Davis DR grading: 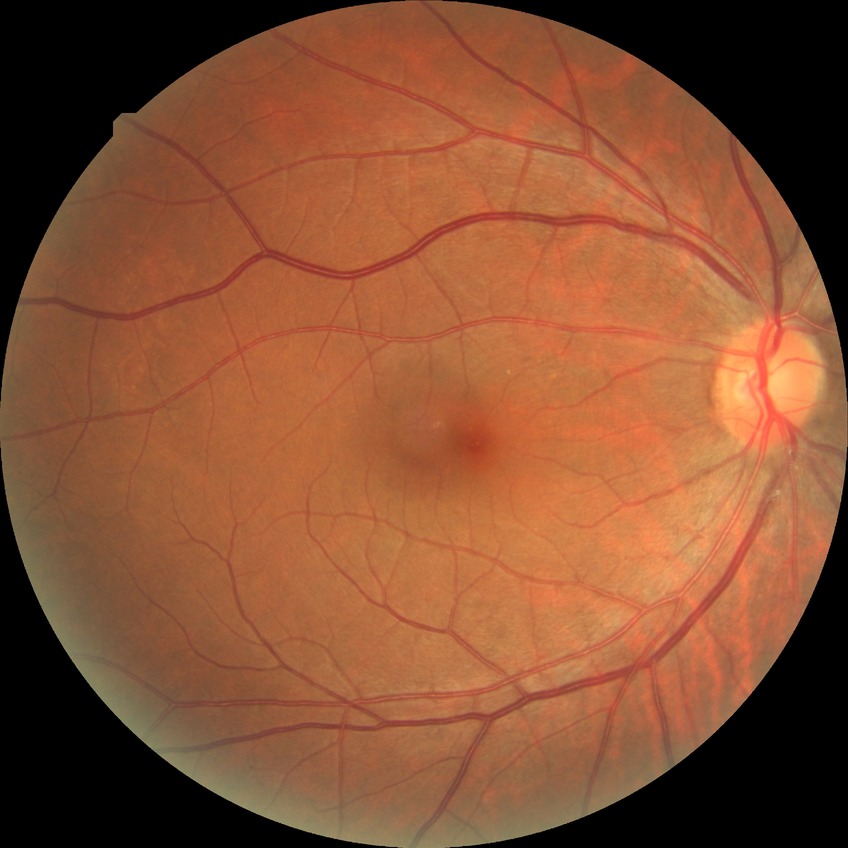

diabetic retinopathy (DR)@NDR (no diabetic retinopathy).